Captured on a Remidio FOP fundus camera
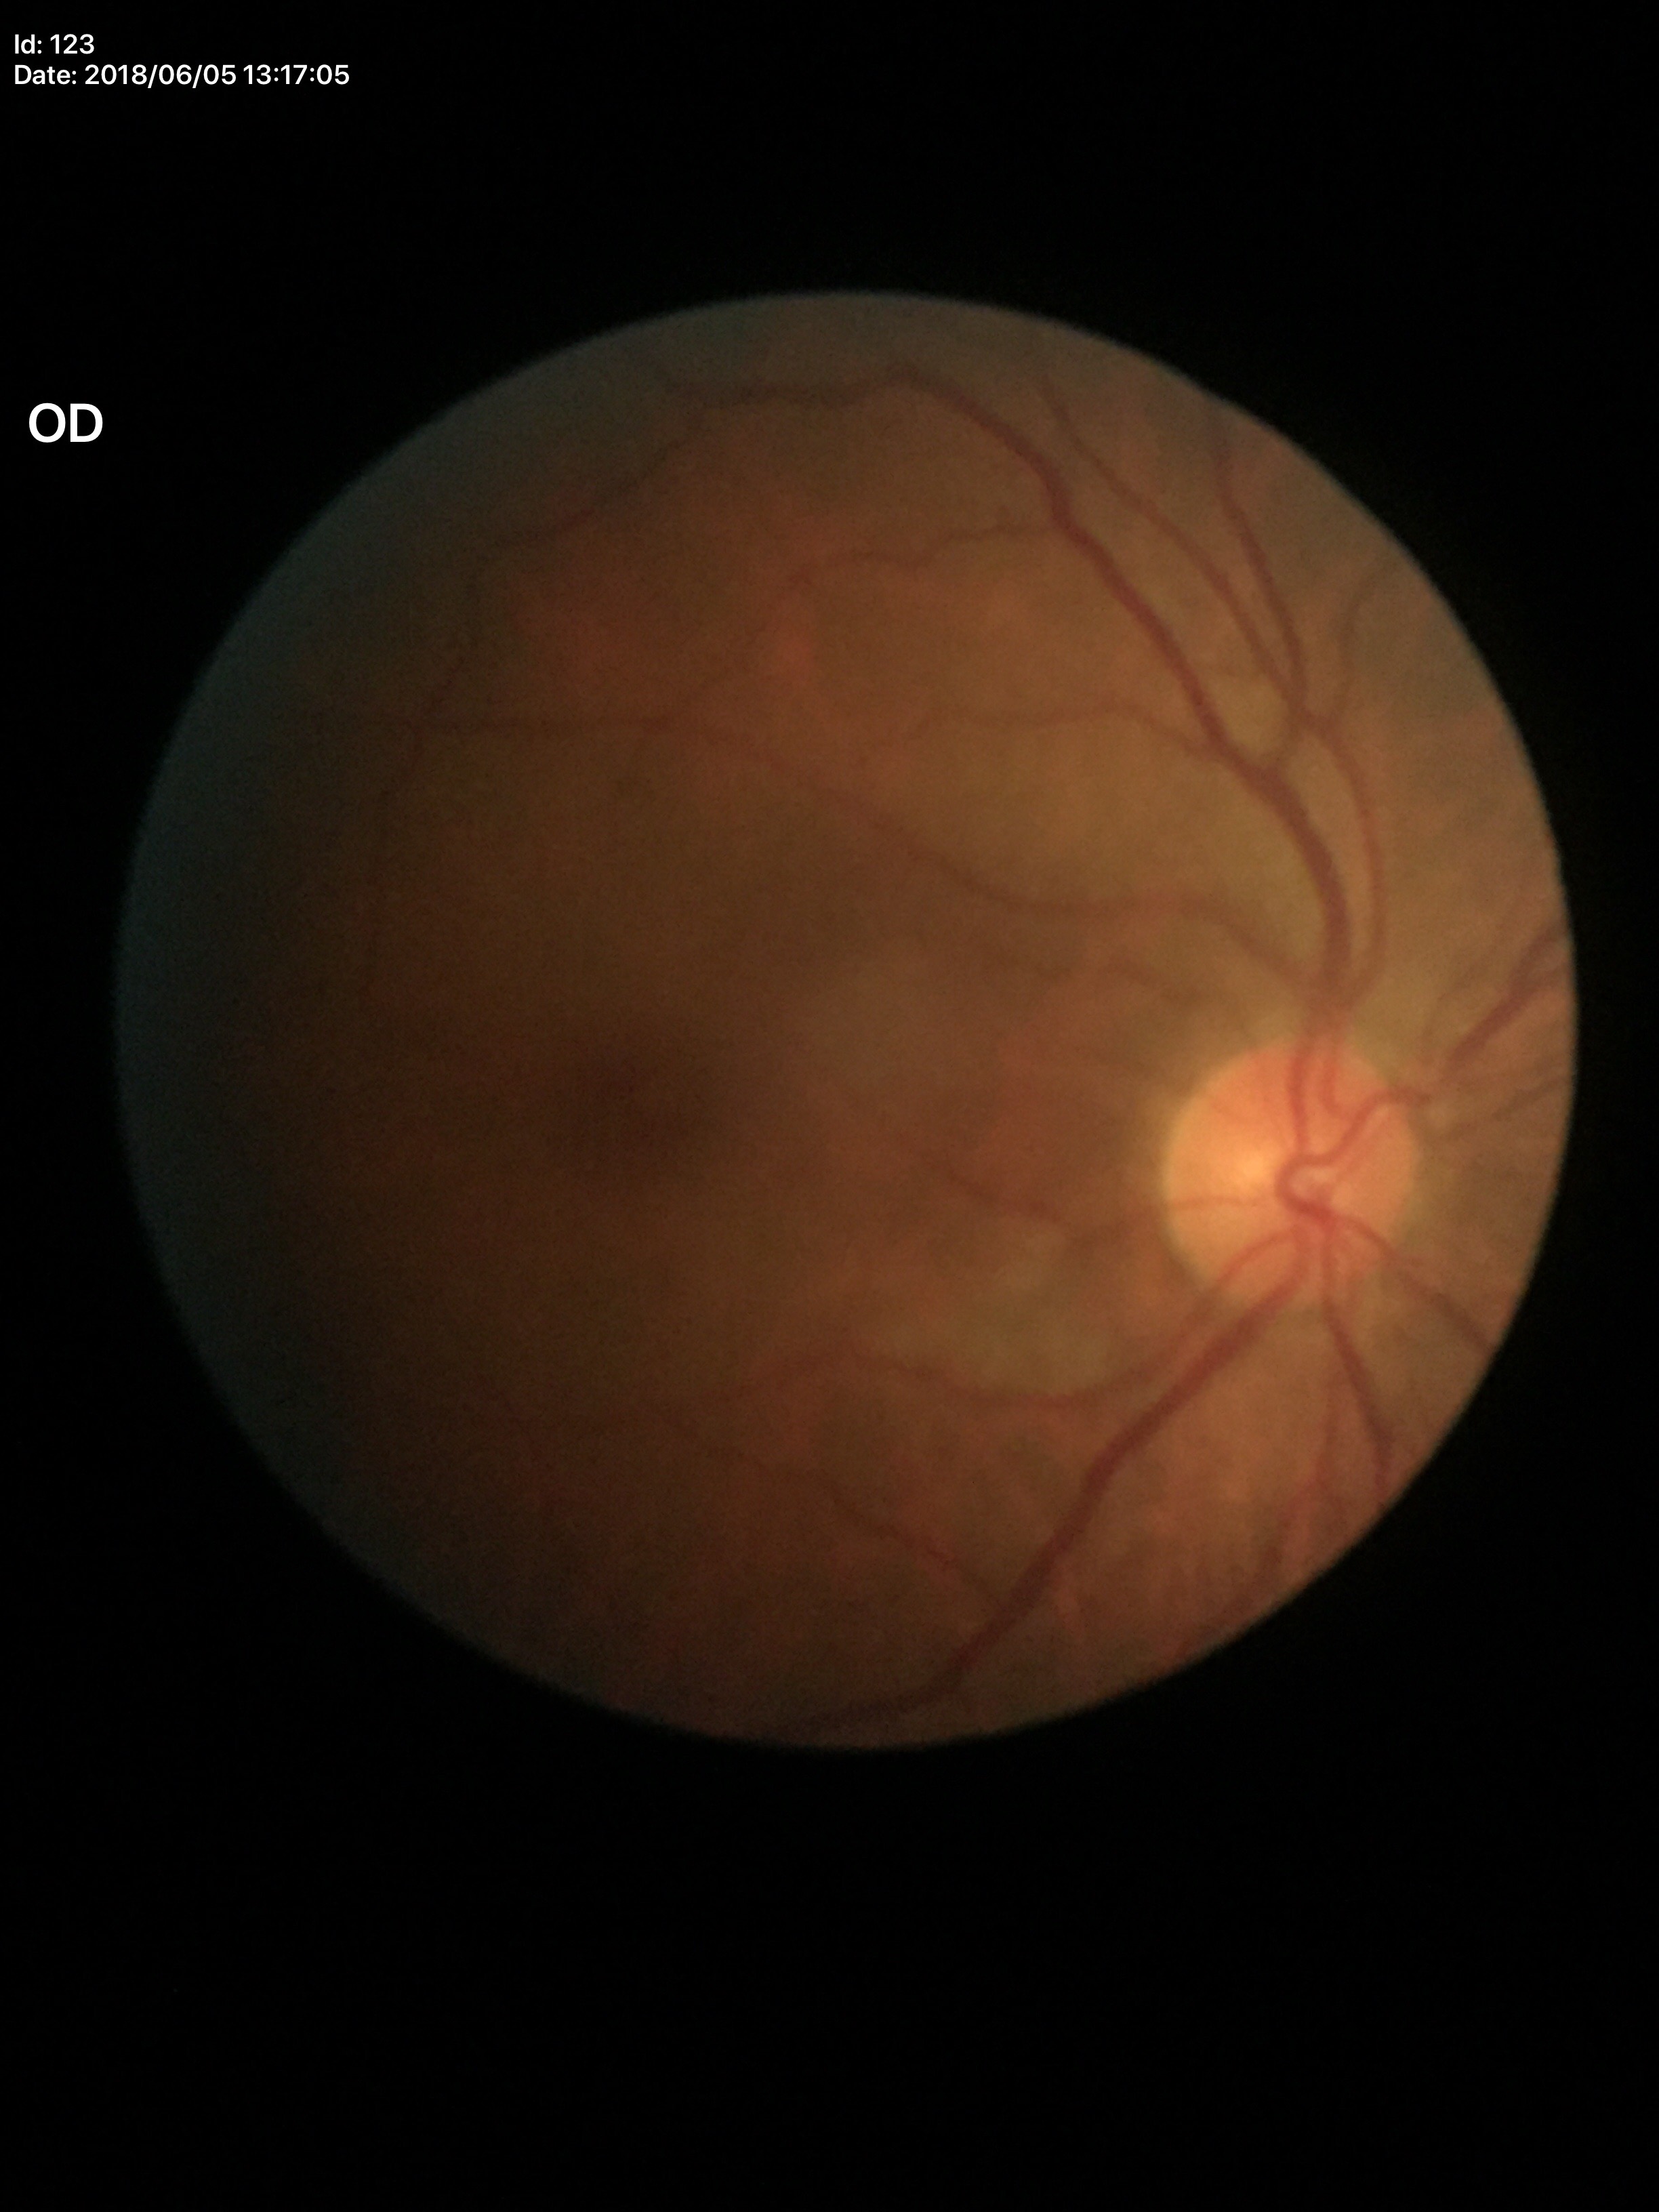

No glaucomatous optic neuropathy. Vertical CDR: 0.45. Horizontal cup-to-disc ratio: 0.46.